Wide-field contact fundus photograph of an infant:
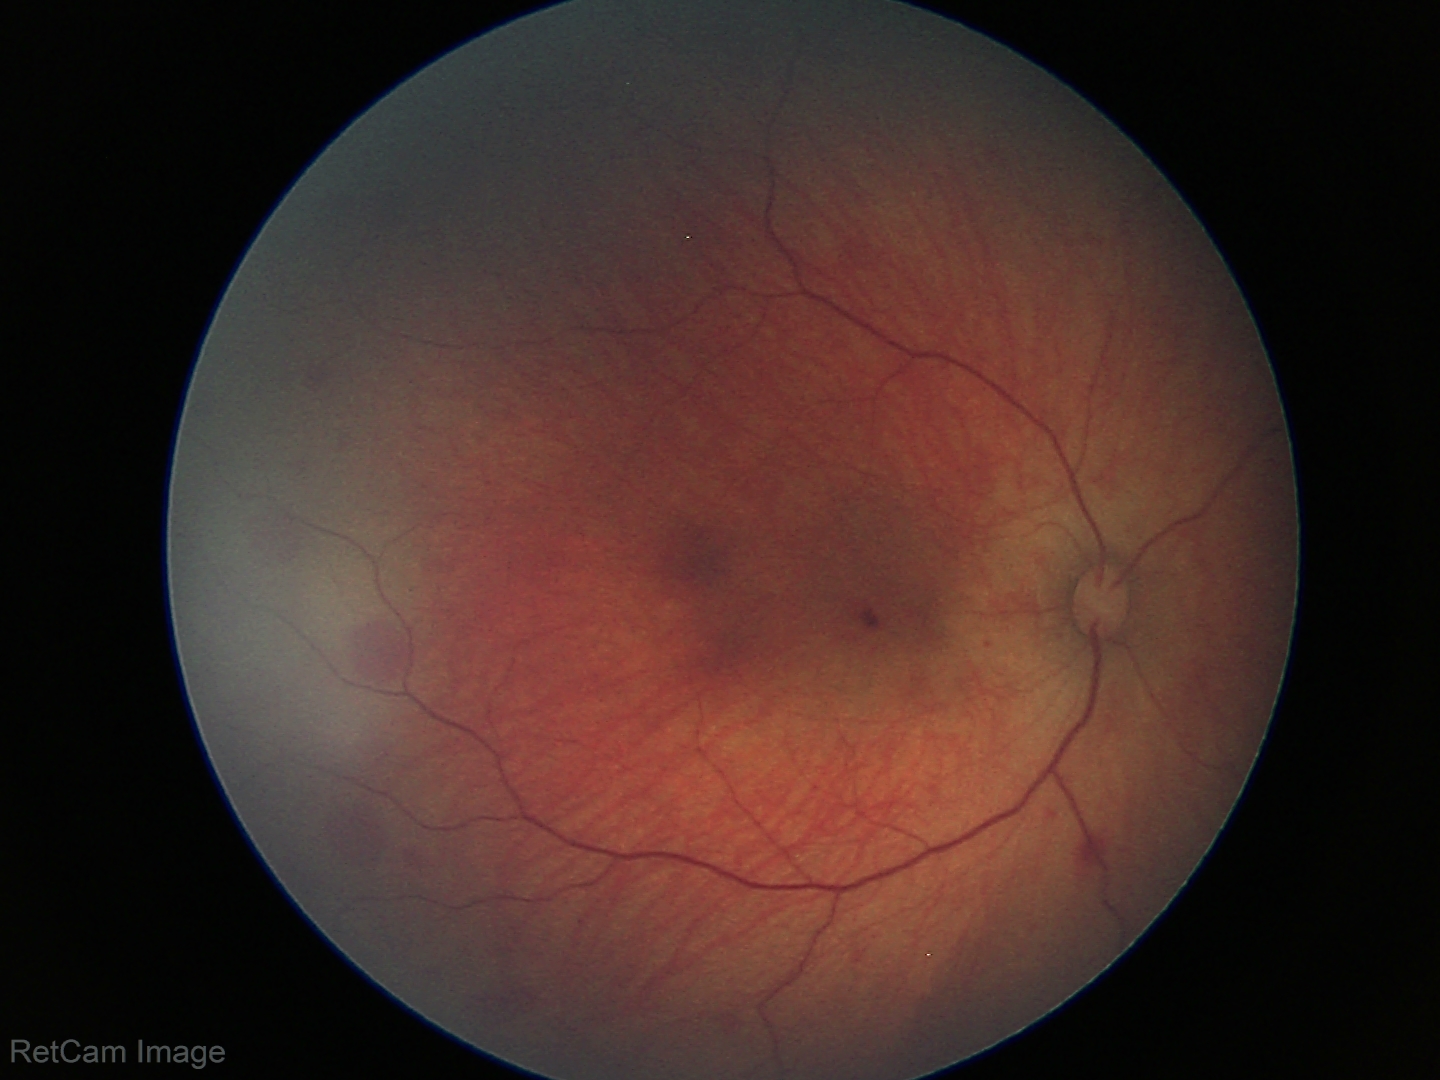

From an examination with diagnosis of retinal hemorrhages.